Retinal fundus photograph
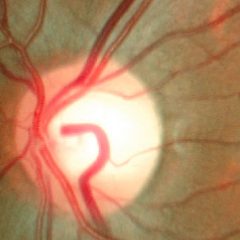
The image shows no glaucomatous optic neuropathy.